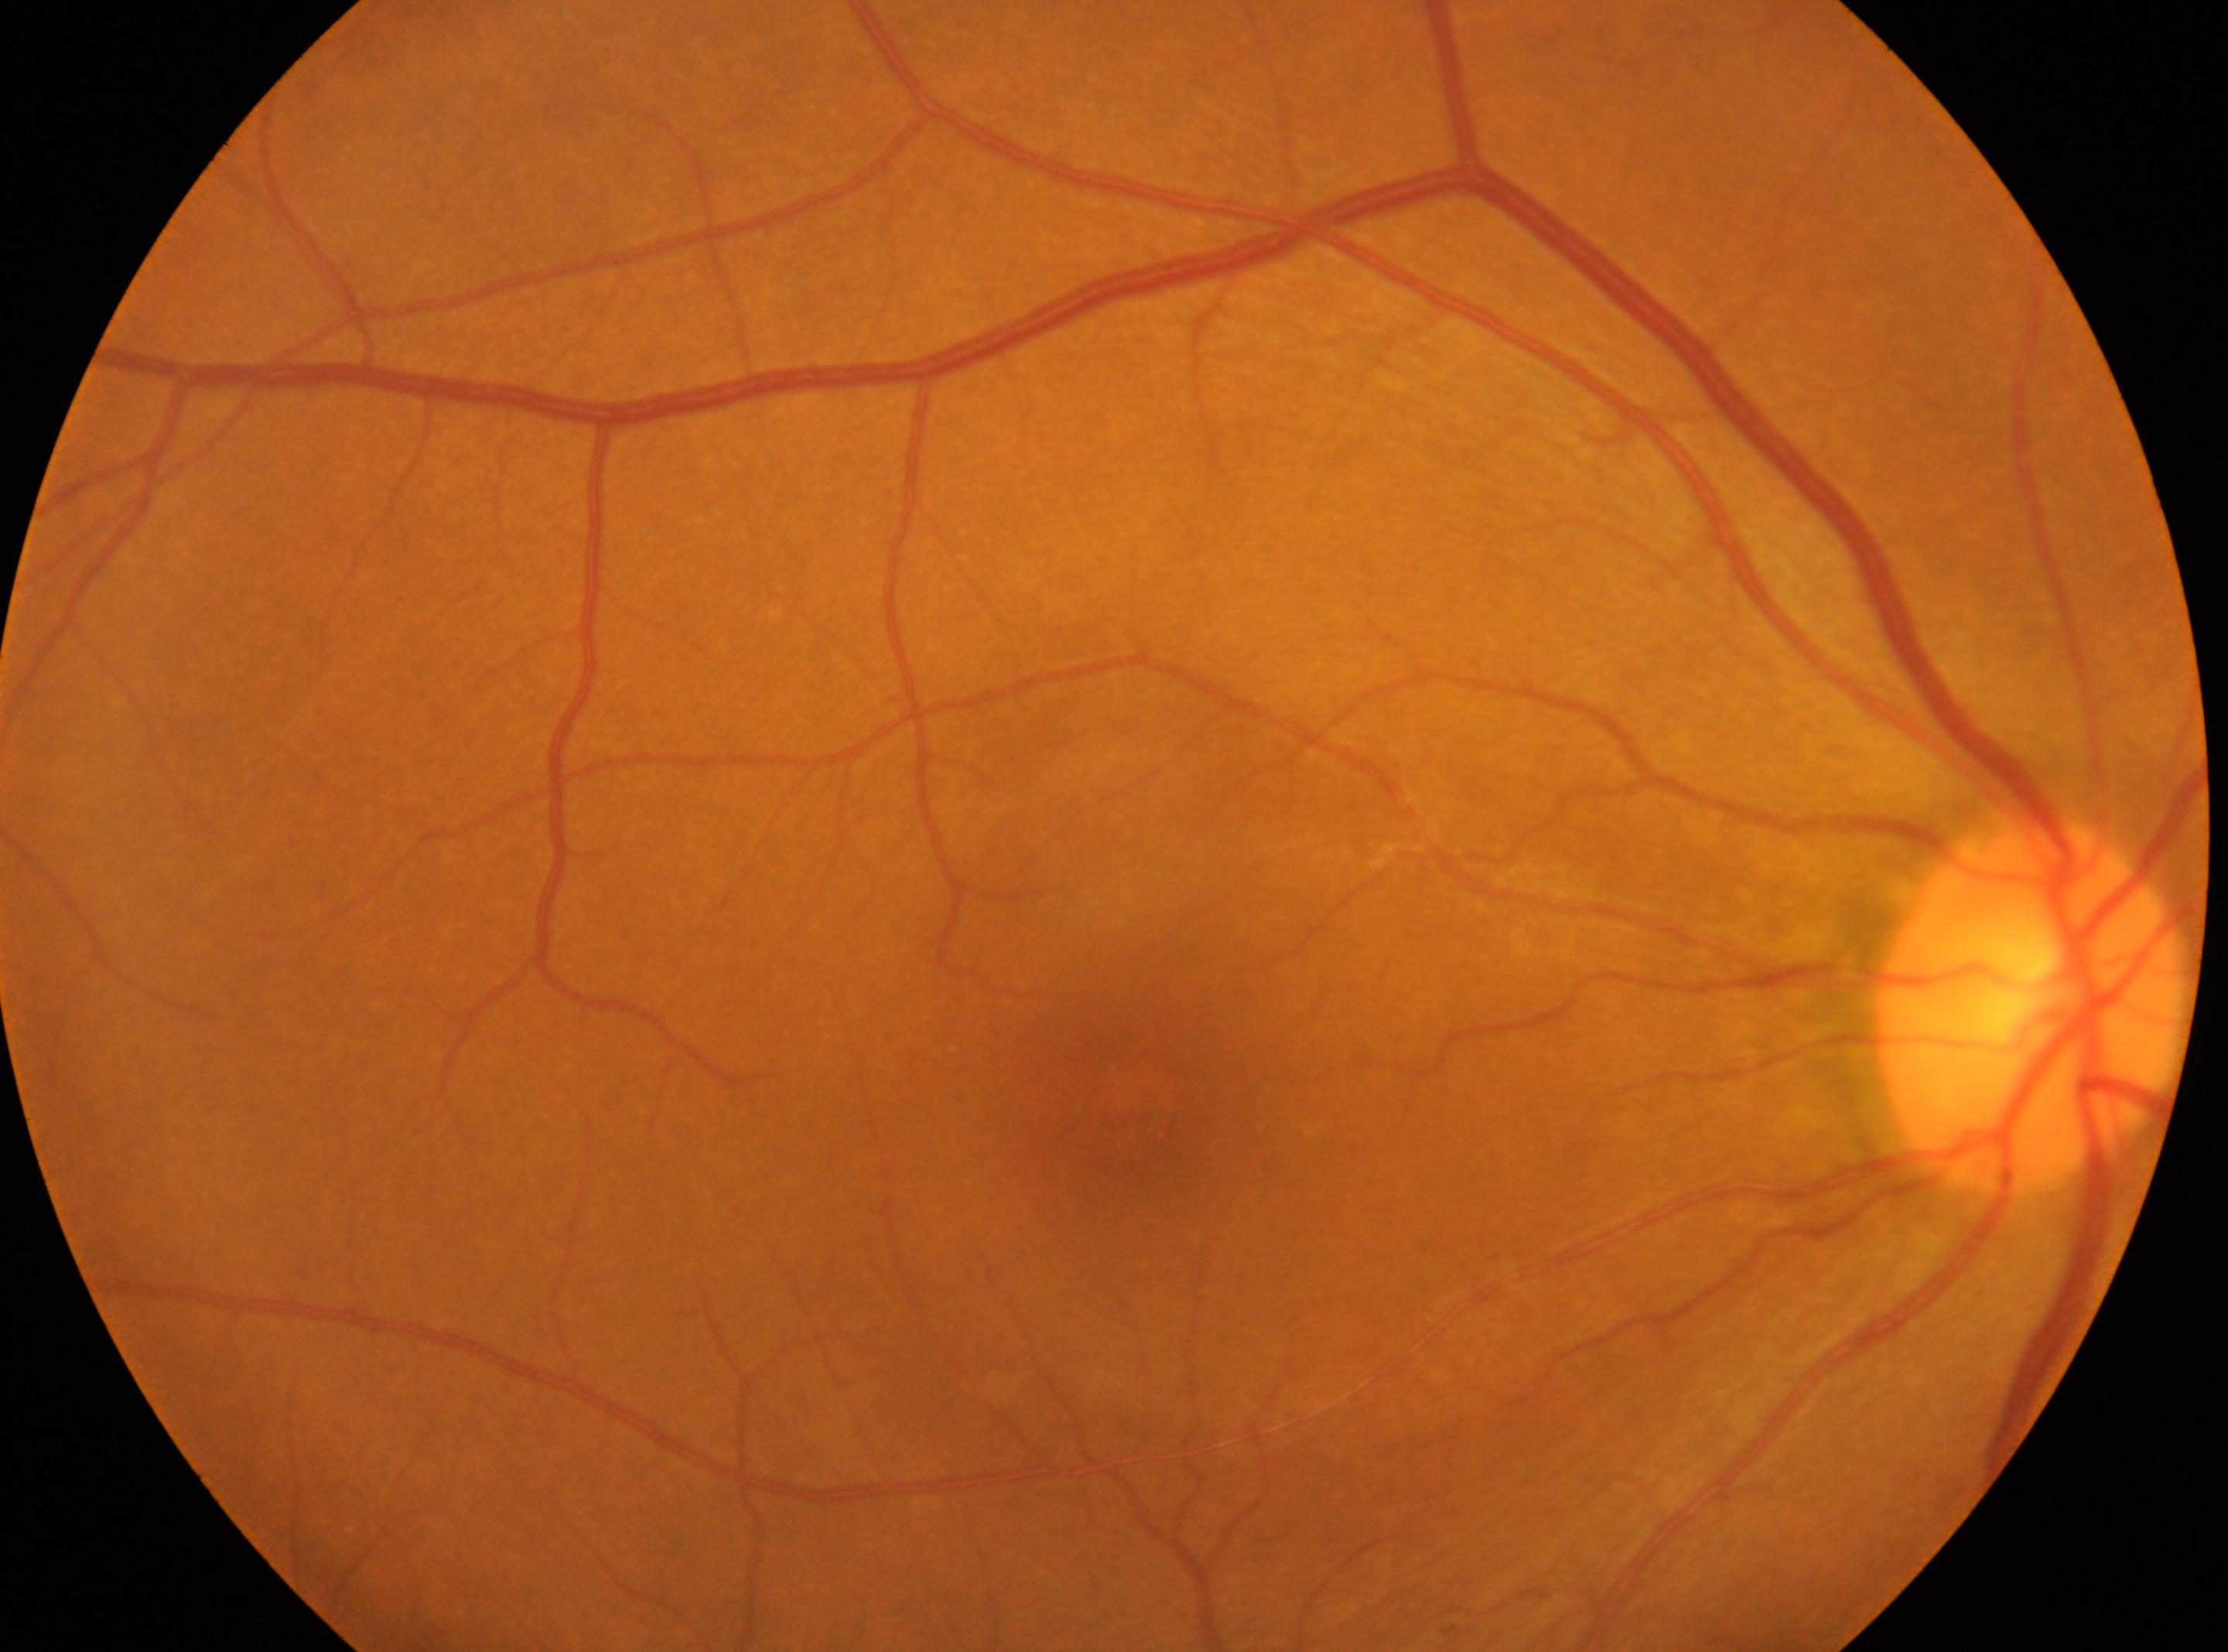
| field | value |
|---|---|
| optic disc | 2033, 1006 |
| laterality | right eye |
| fovea center | 1129, 1112 |
| diabetic retinopathy grade | 0 |
| DR impression | No diabetic retinal disease findings |